Infant wide-field fundus photograph
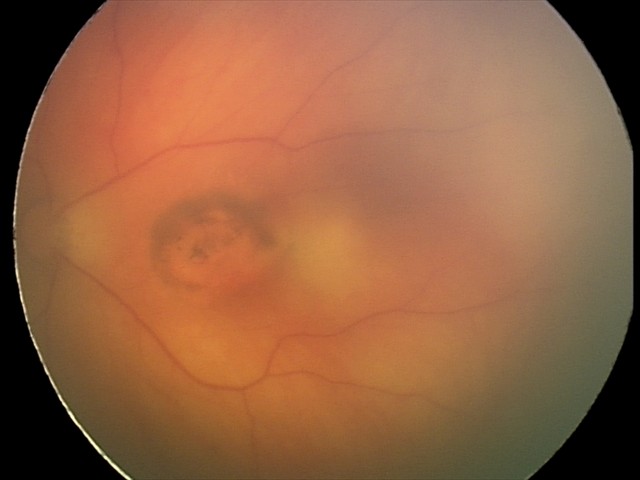

Q: What is the diagnosis from this examination?
A: toxoplasmosis chorioretinitis